130° field of view (Natus RetCam Envision); pediatric retinal photograph (wide-field); 1440x1080.
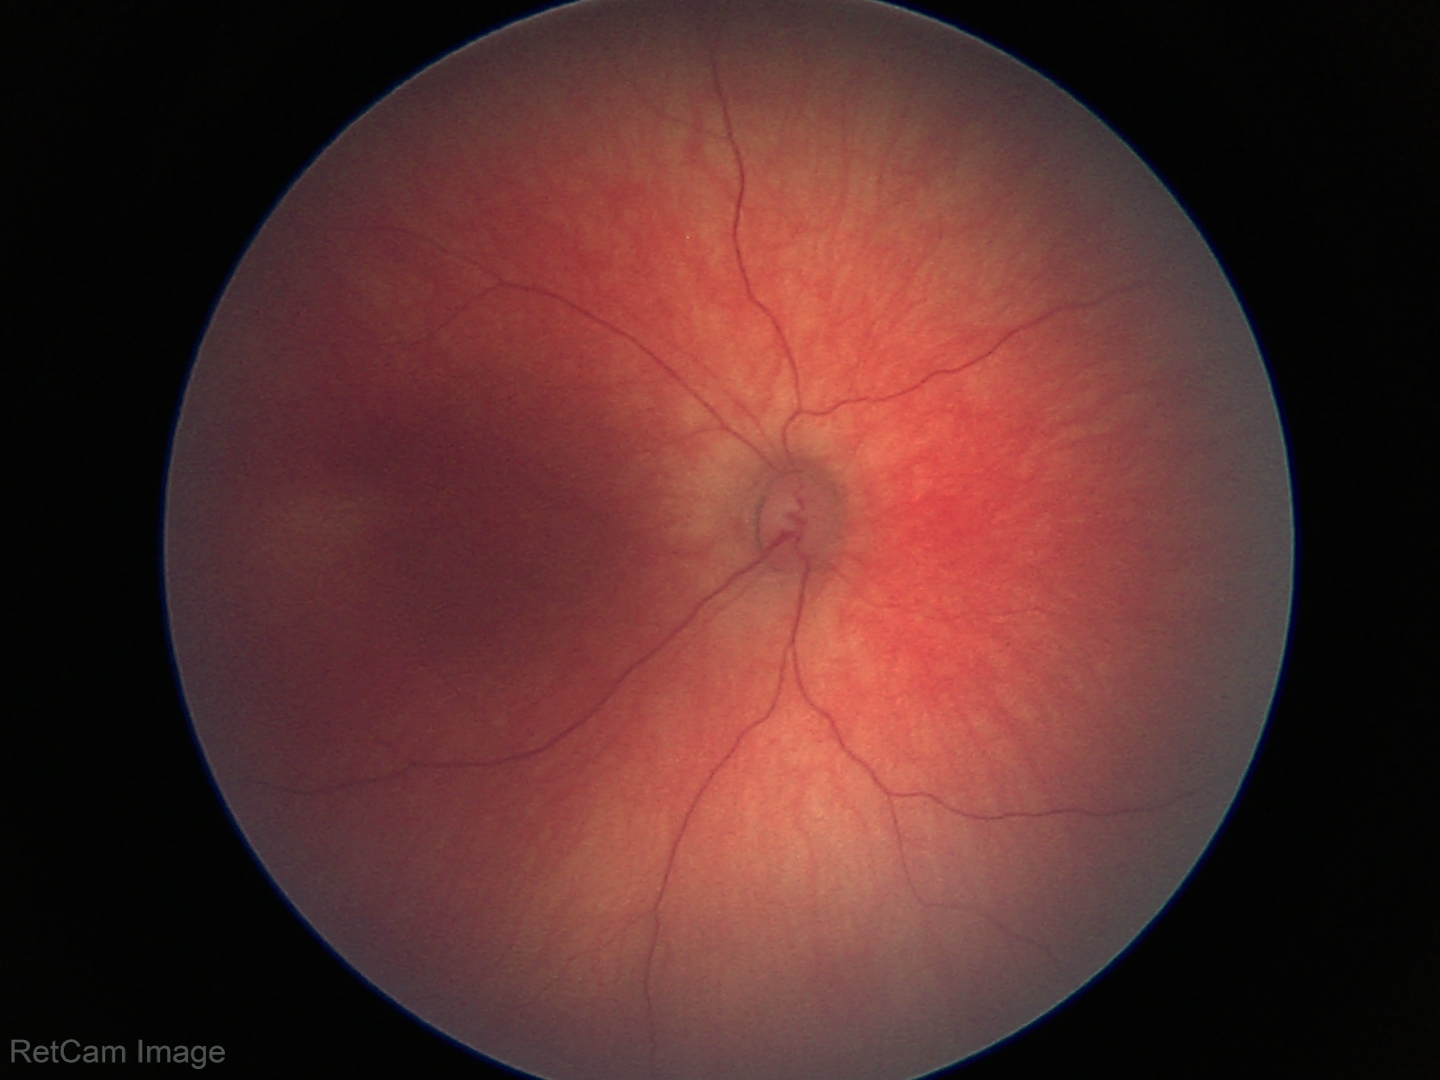

Screening diagnosis = physiological